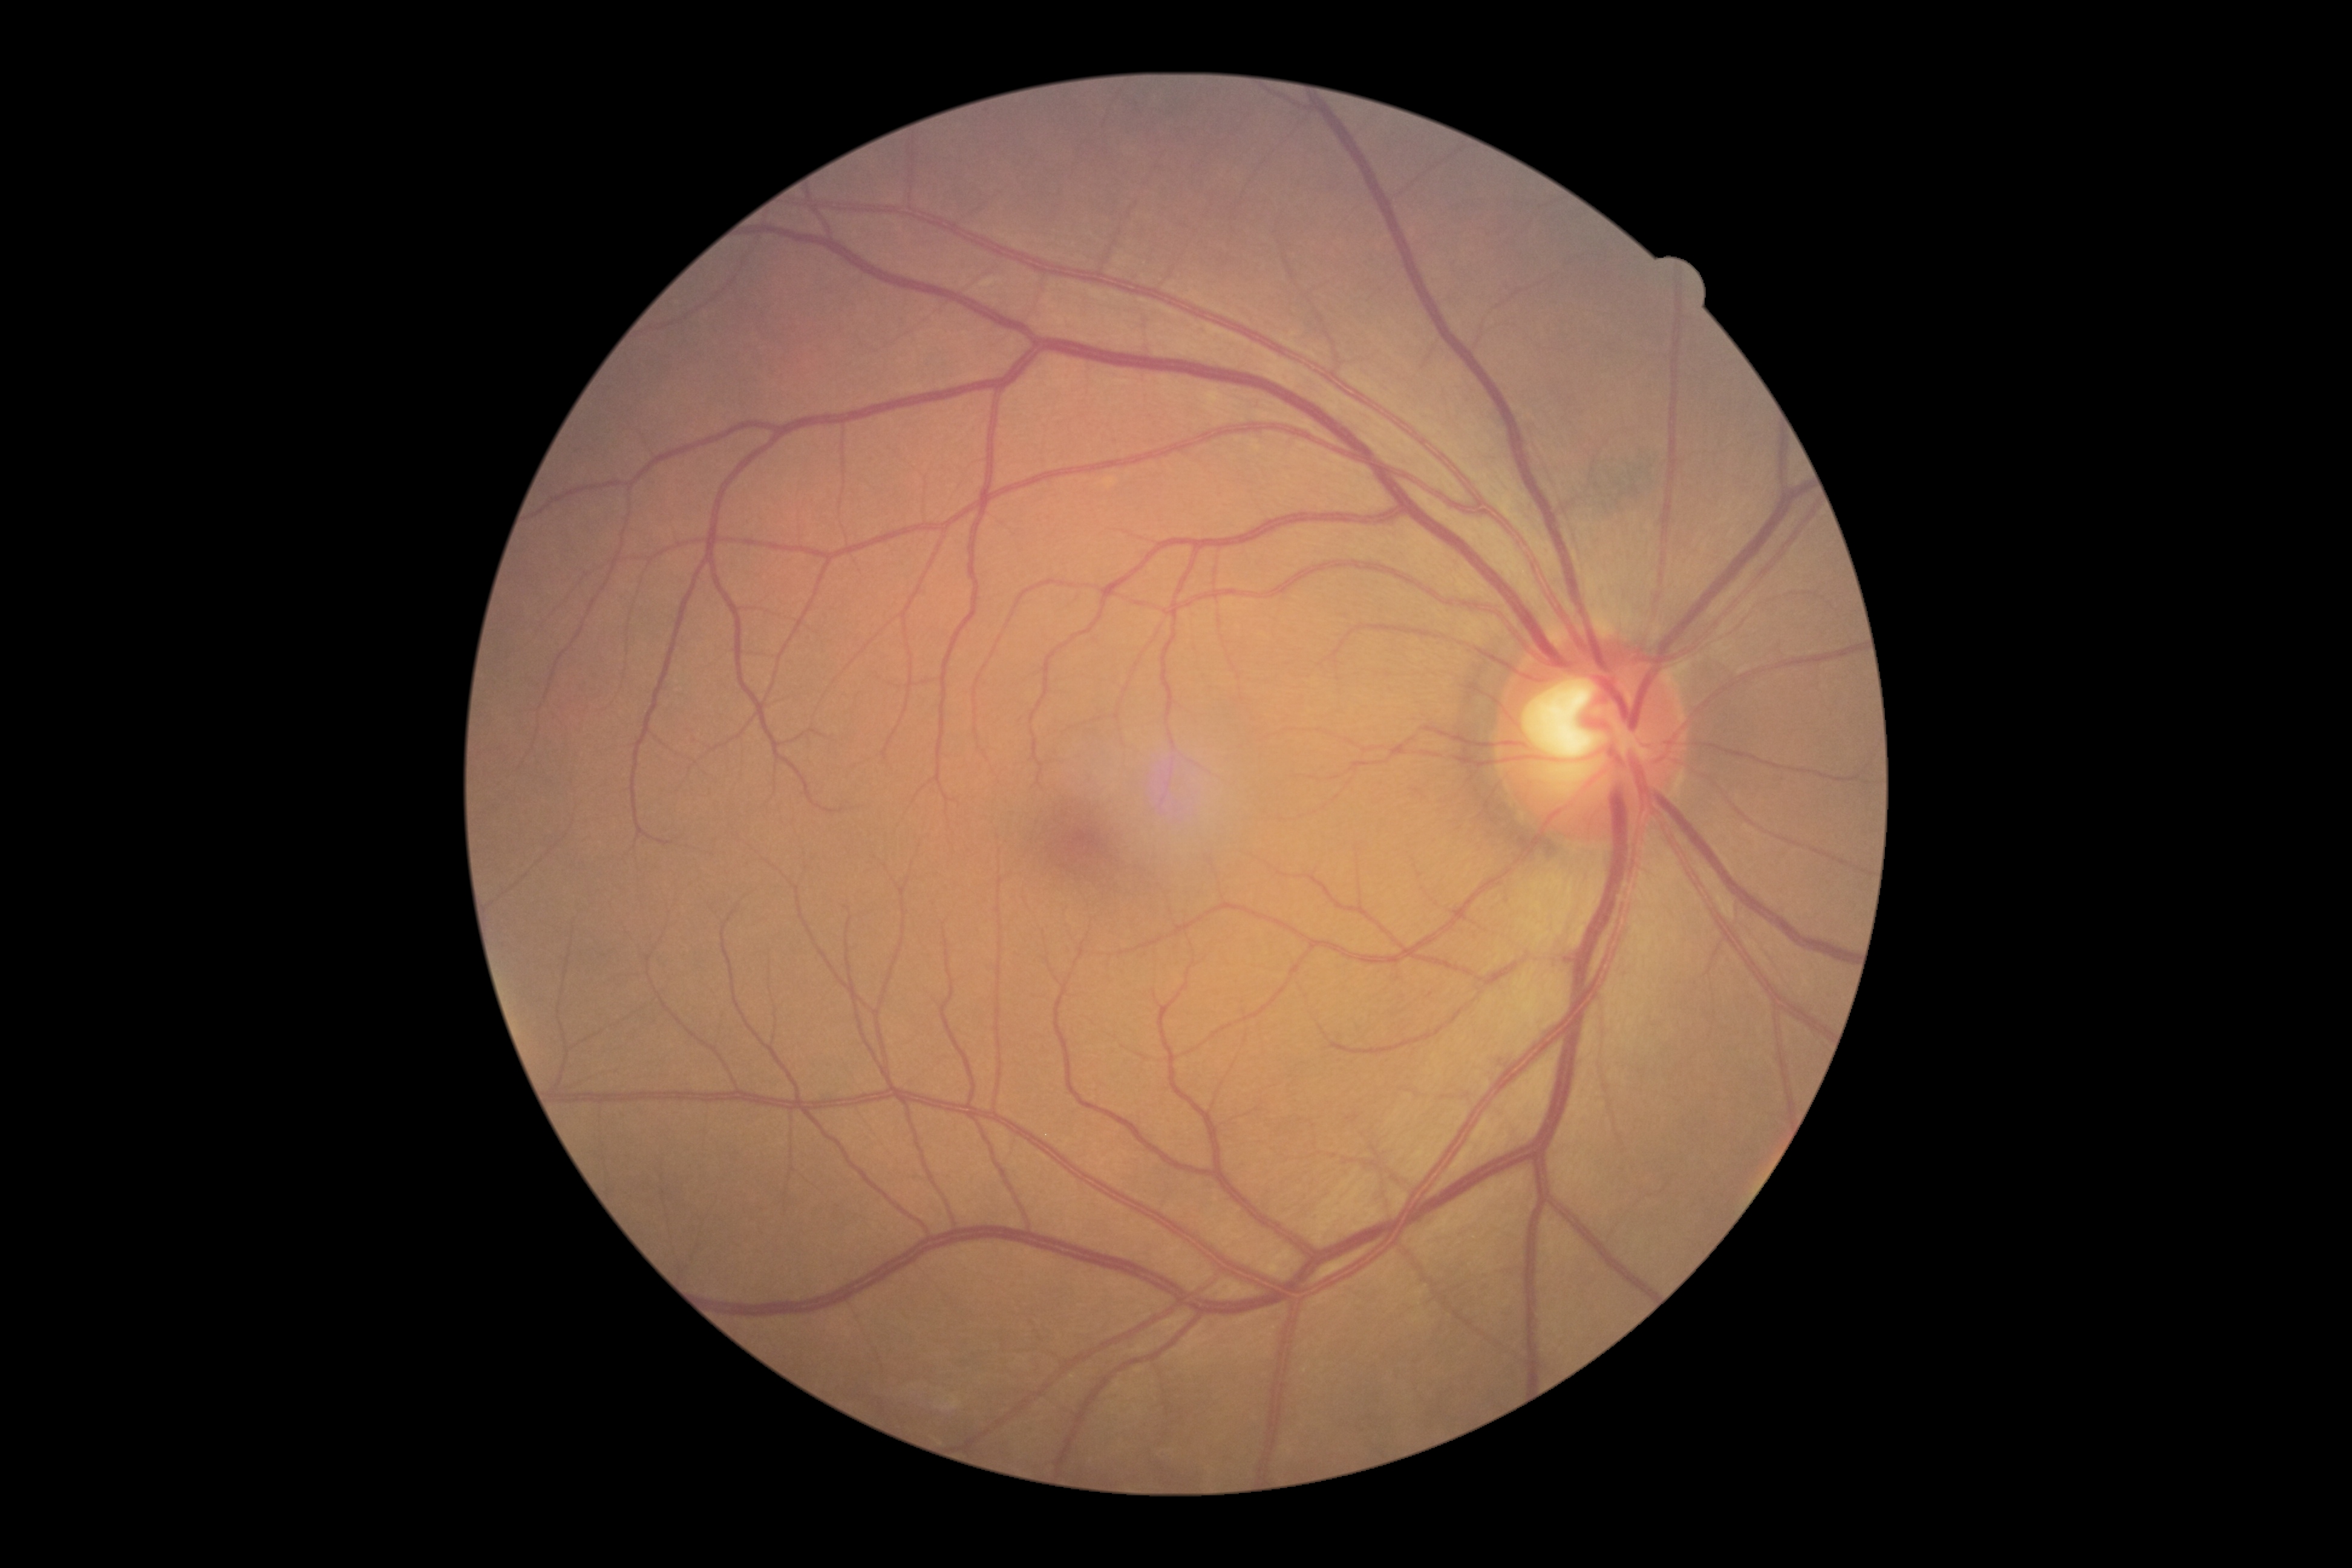 DR stage: no apparent retinopathy (grade 0) — no visible signs of diabetic retinopathy, DR impression: no signs of DR.